2352 x 1568 pixels.
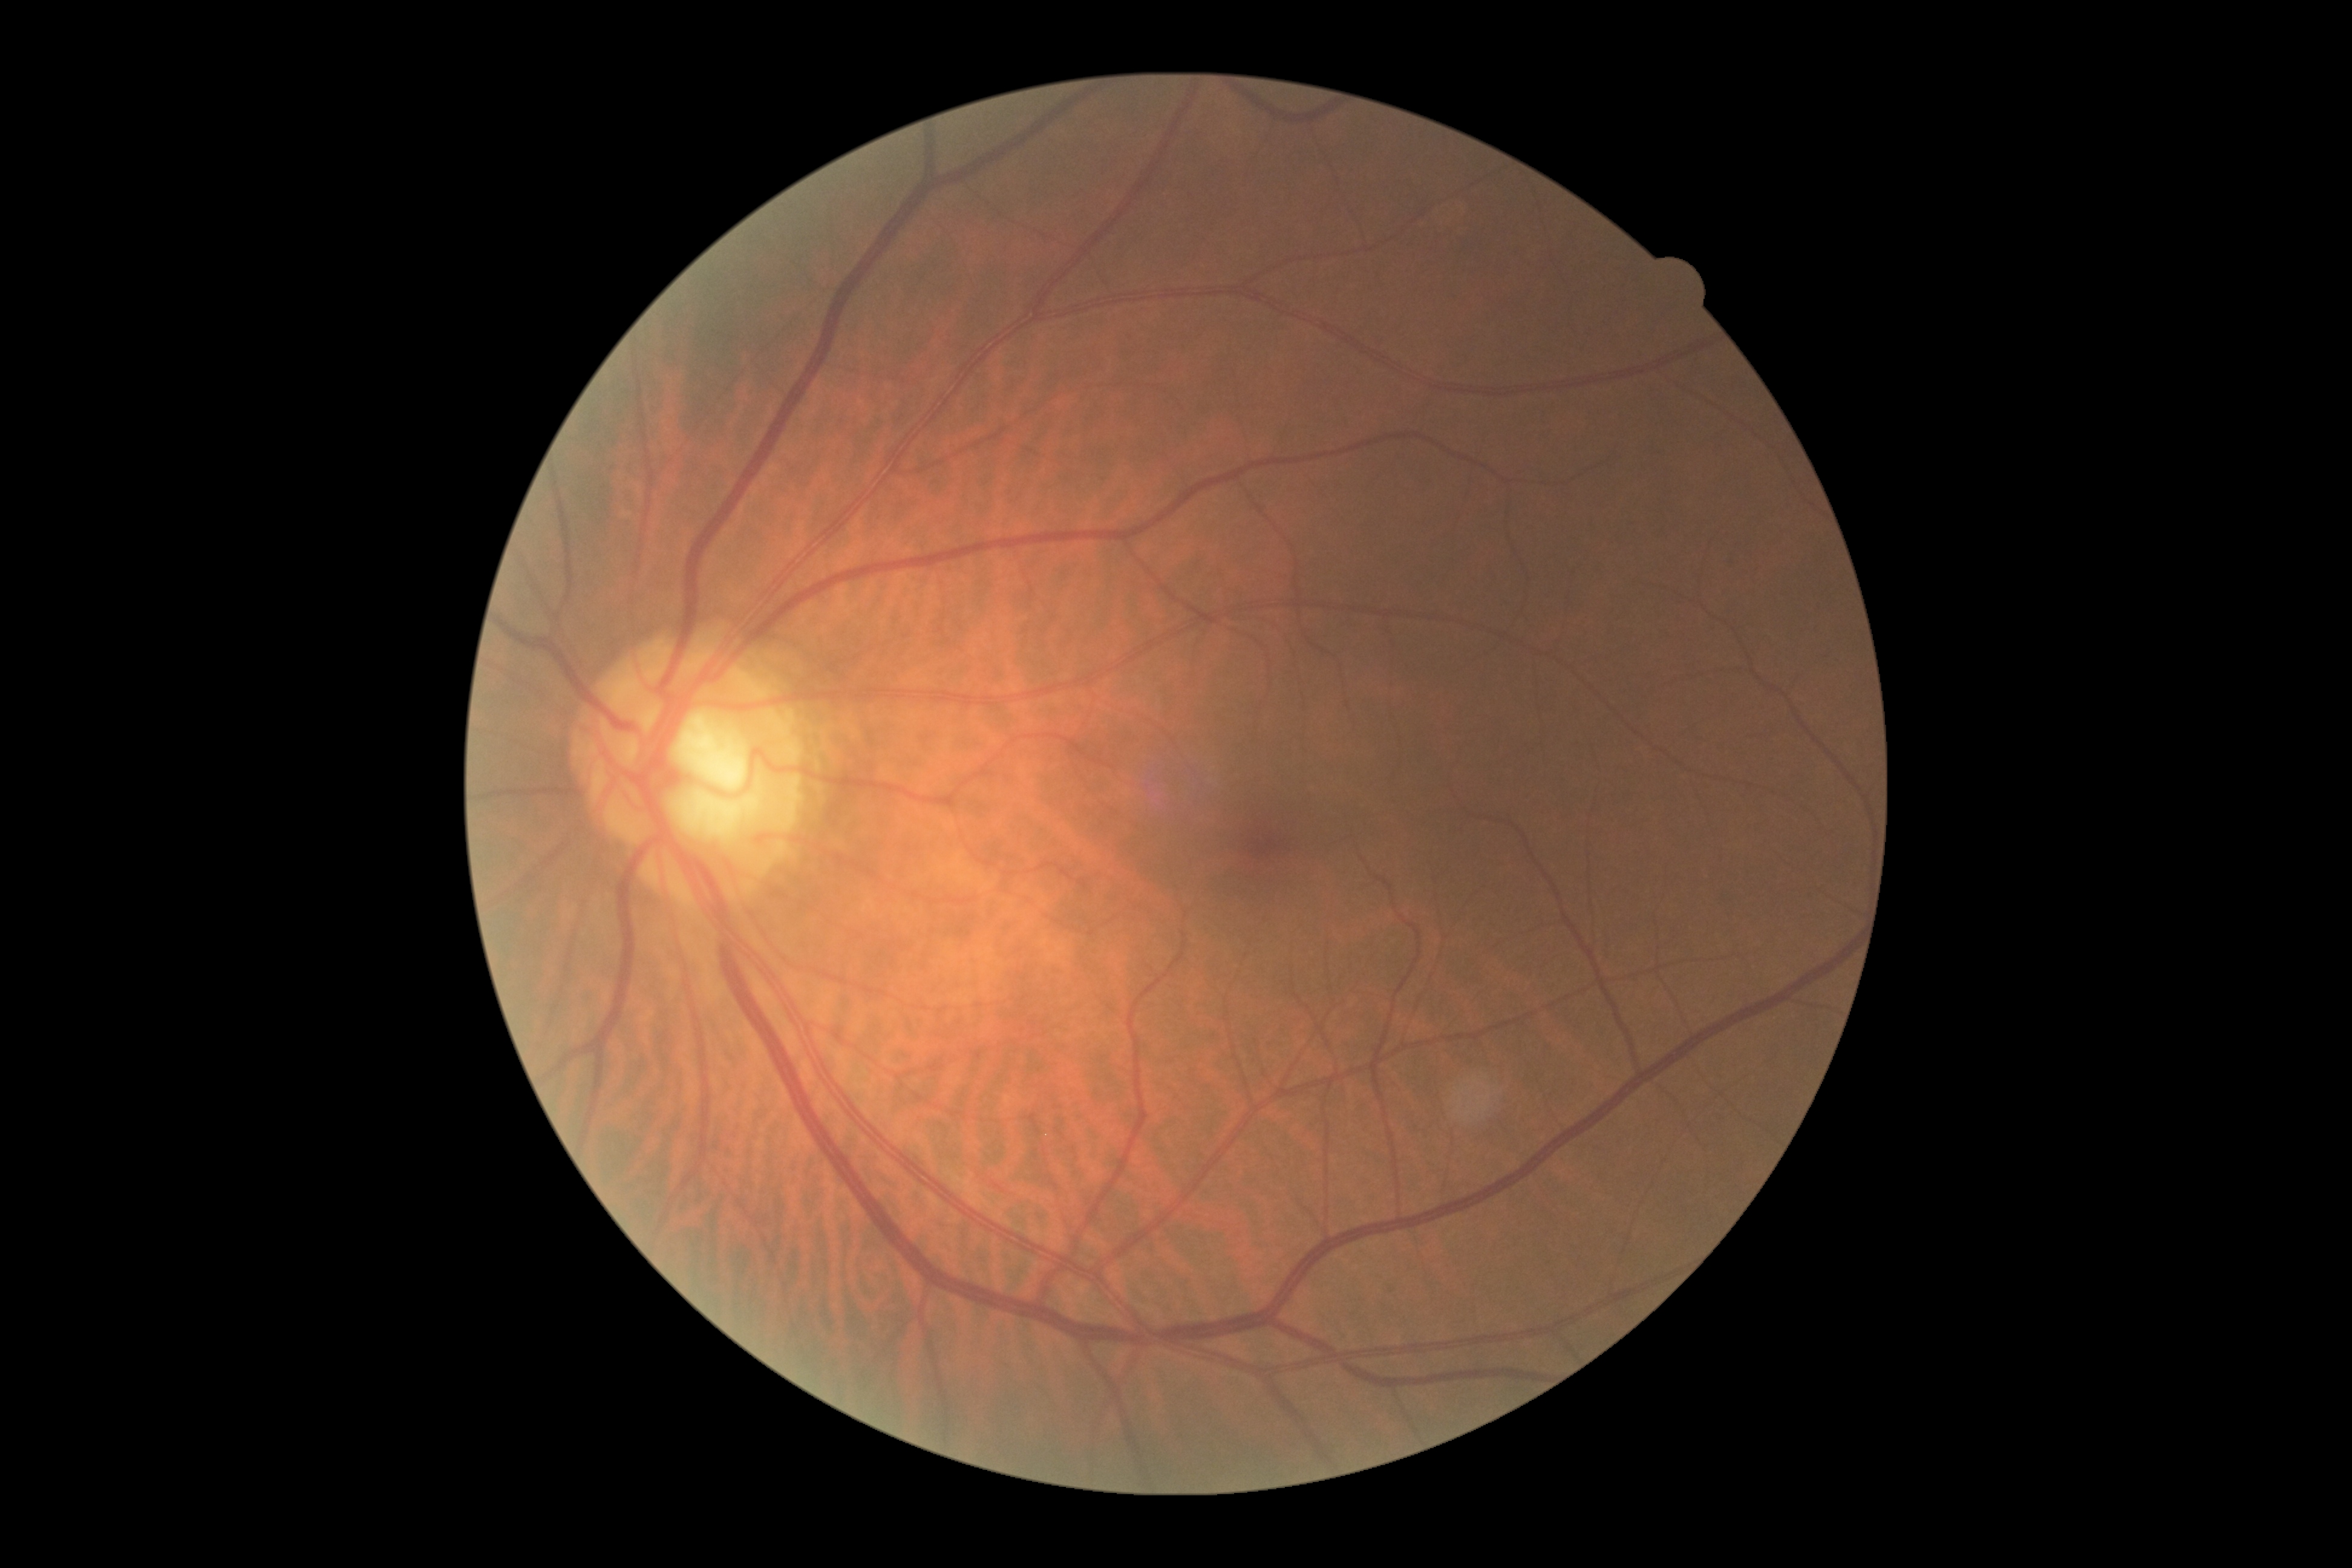 Diabetic retinopathy severity is 0/4.